Camera: Clarity RetCam 3 (130° FOV). Image size 640x480. Wide-field fundus photograph of an infant:
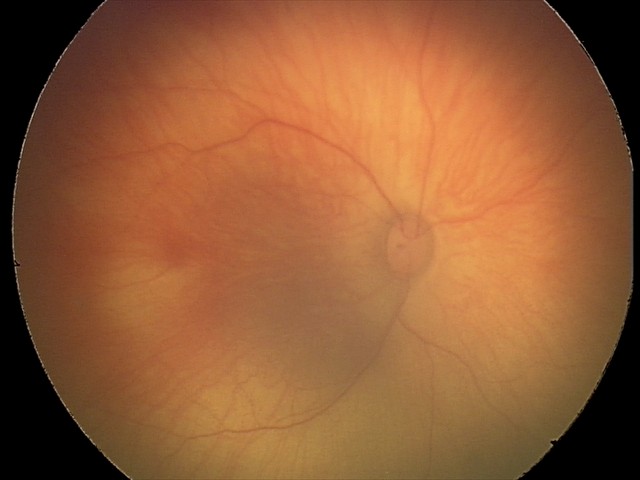

Screening series with retinal hemorrhages.